Retinal fundus photograph · 45° FOV · 2048 x 1536 pixels:
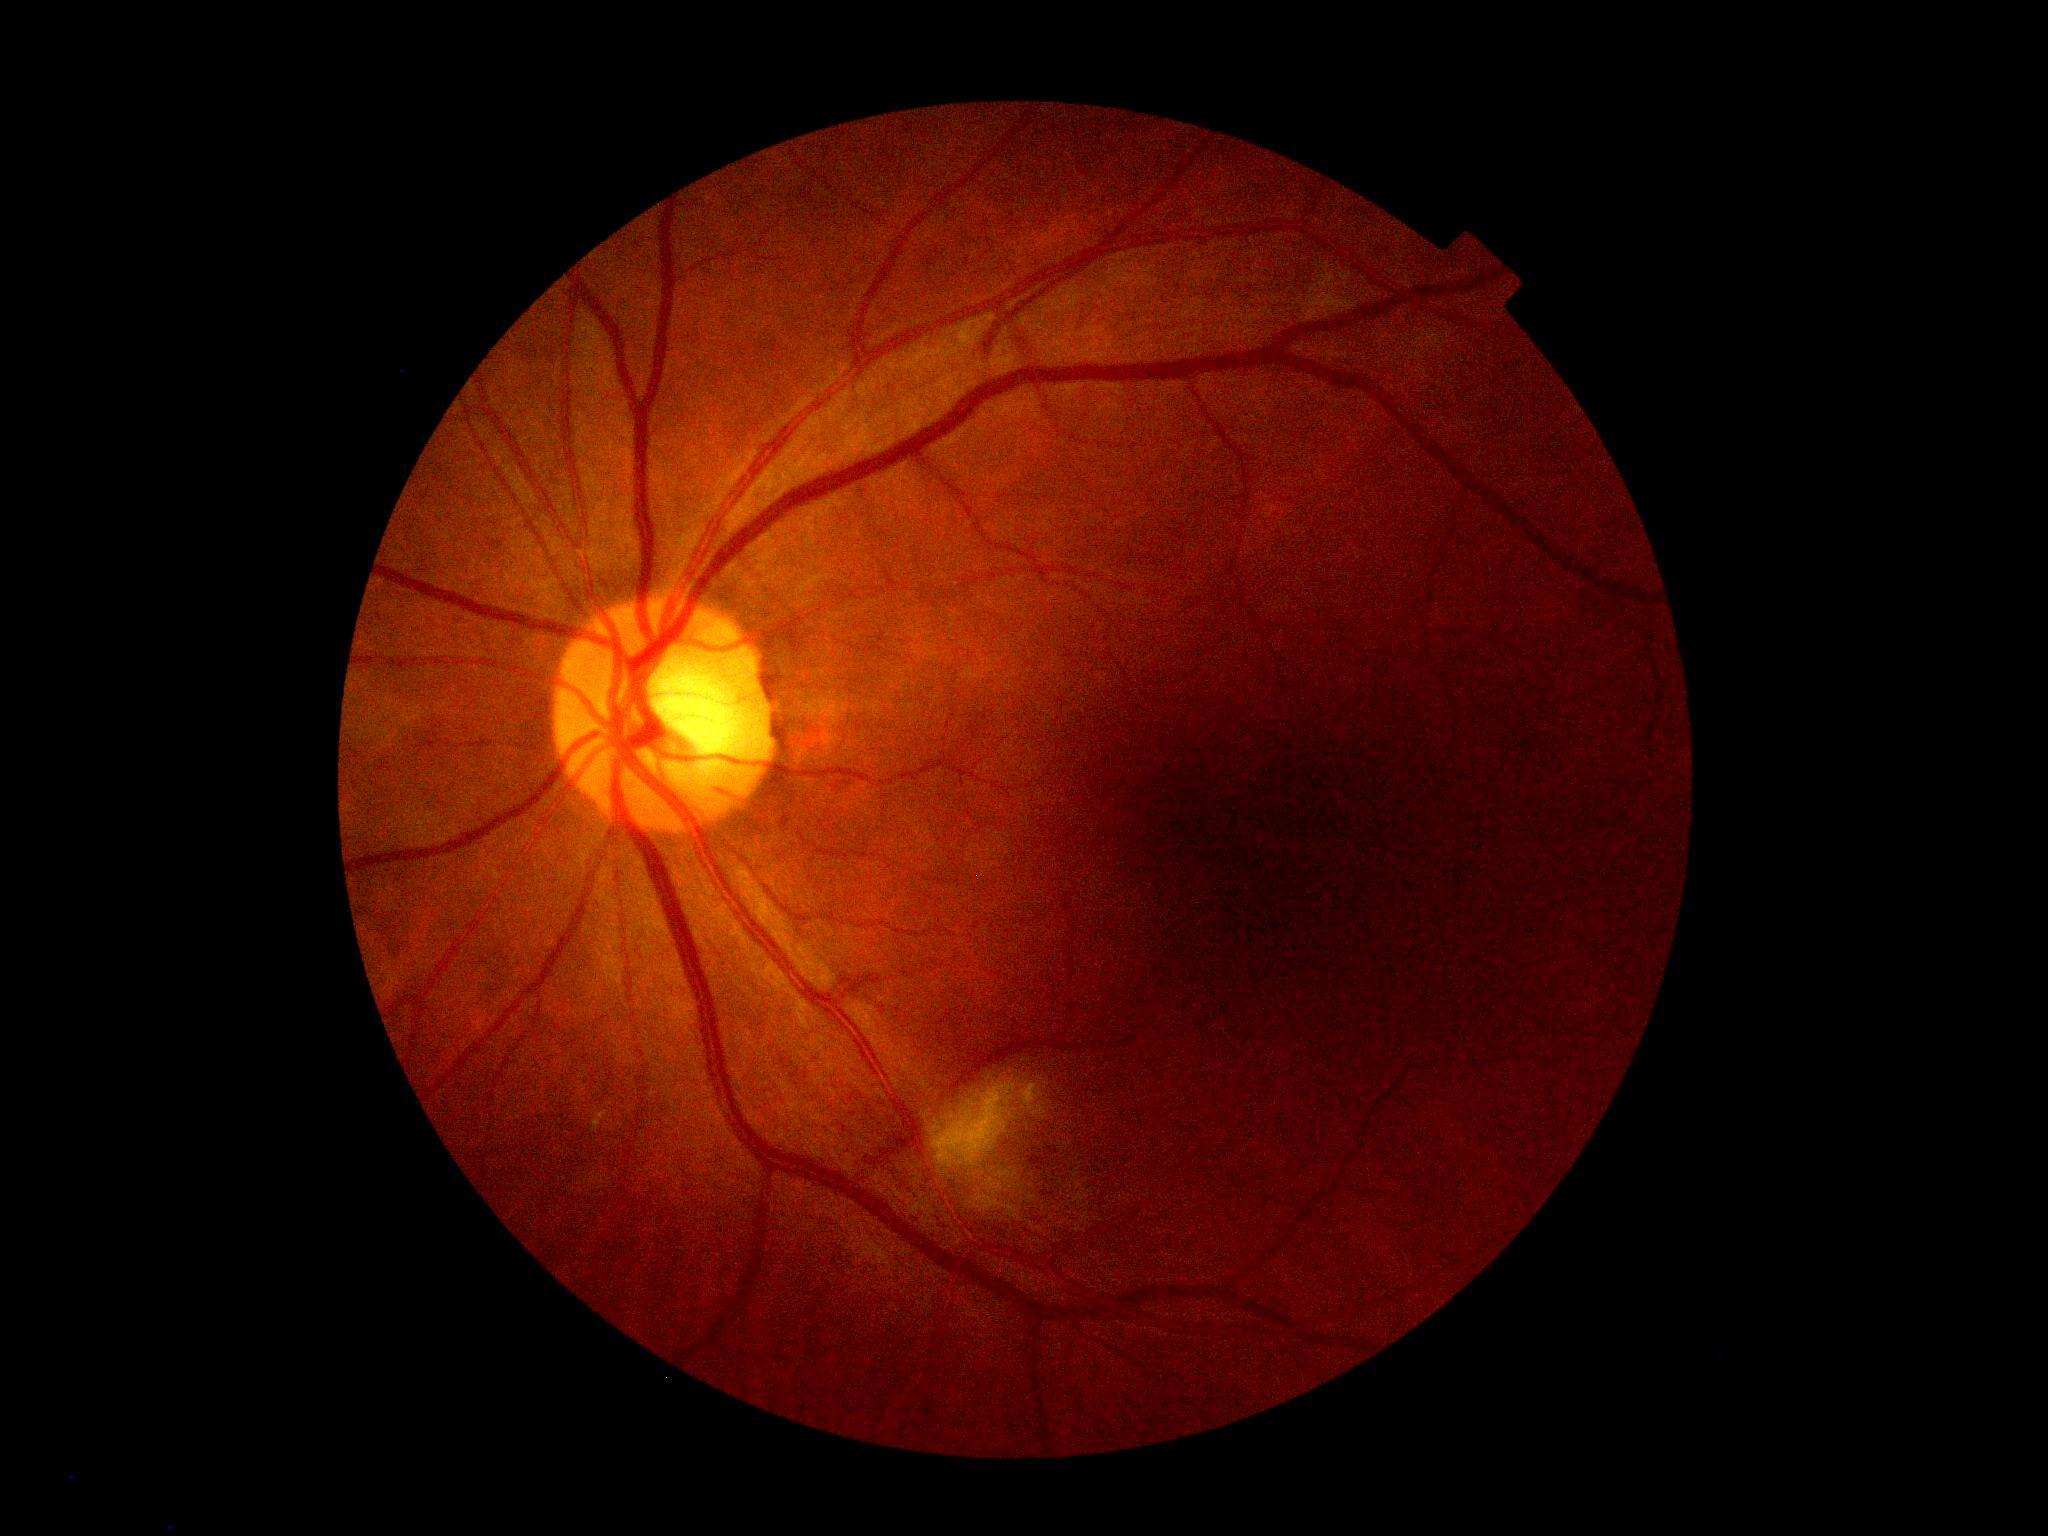

Retinopathy grade: 2.